2352 by 1568 pixels — 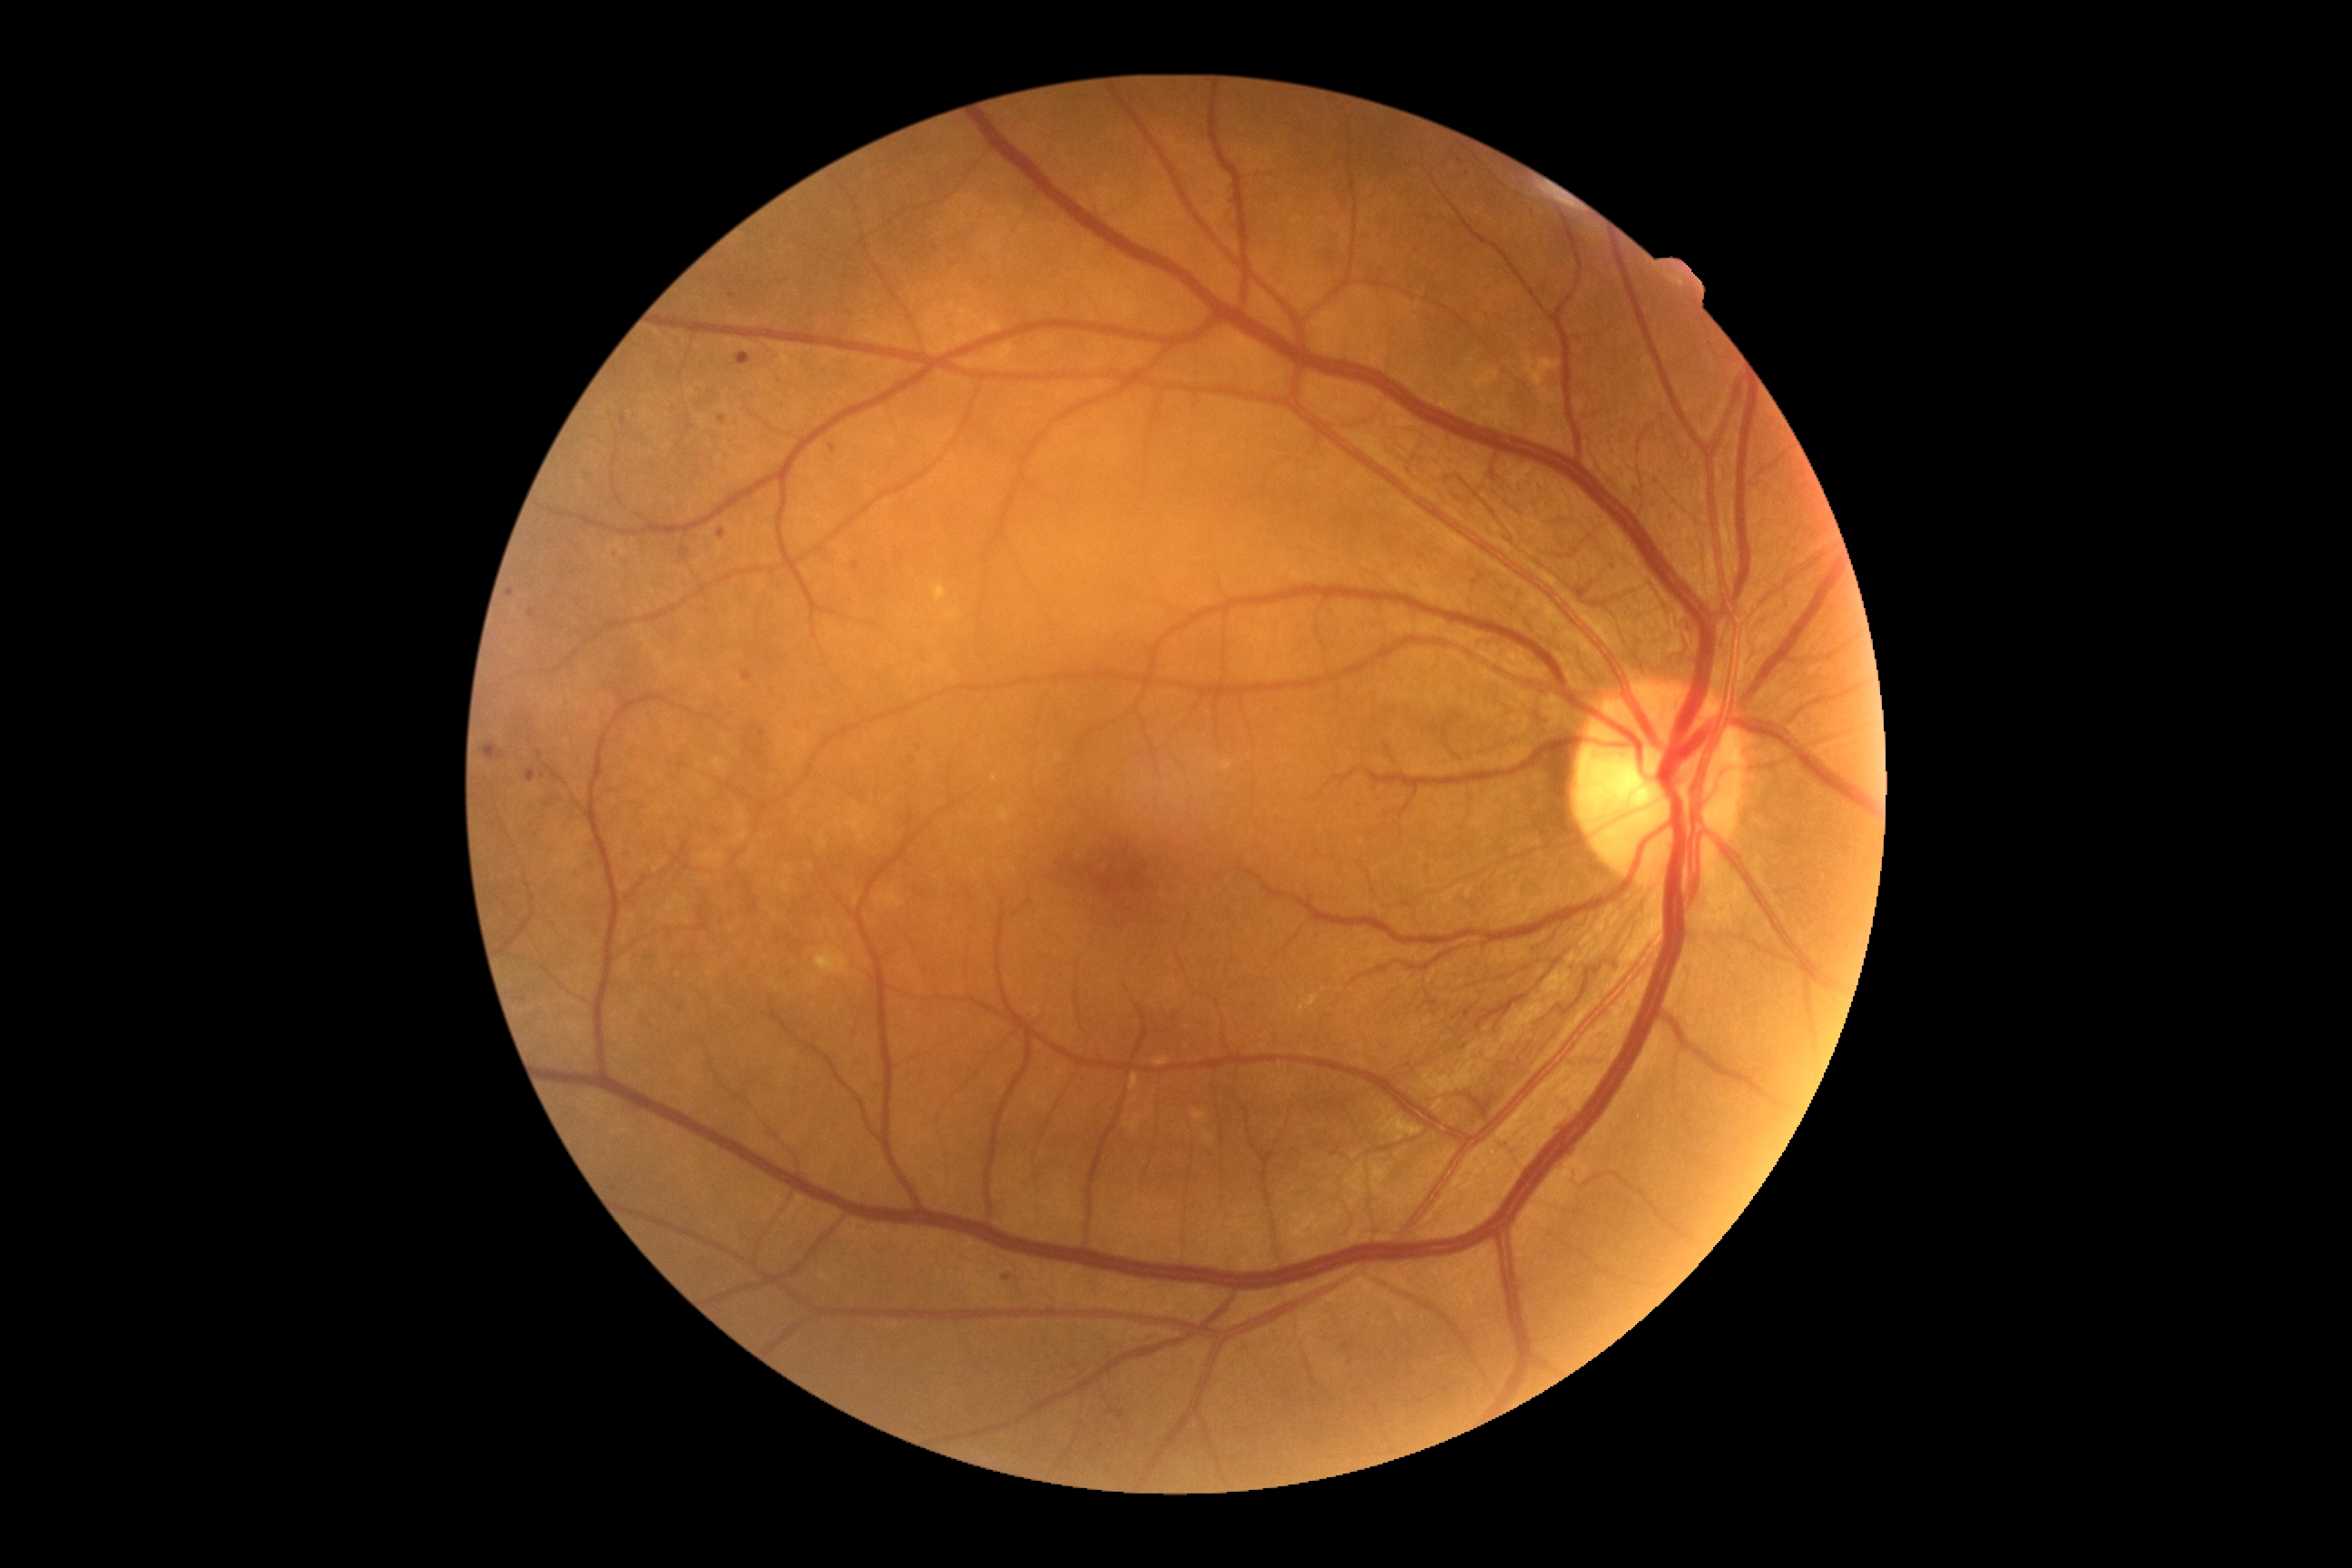
DR class=non-proliferative diabetic retinopathy, DR=grade 3 (severe NPDR).